1932x1916. Color fundus photograph. 45° FOV — 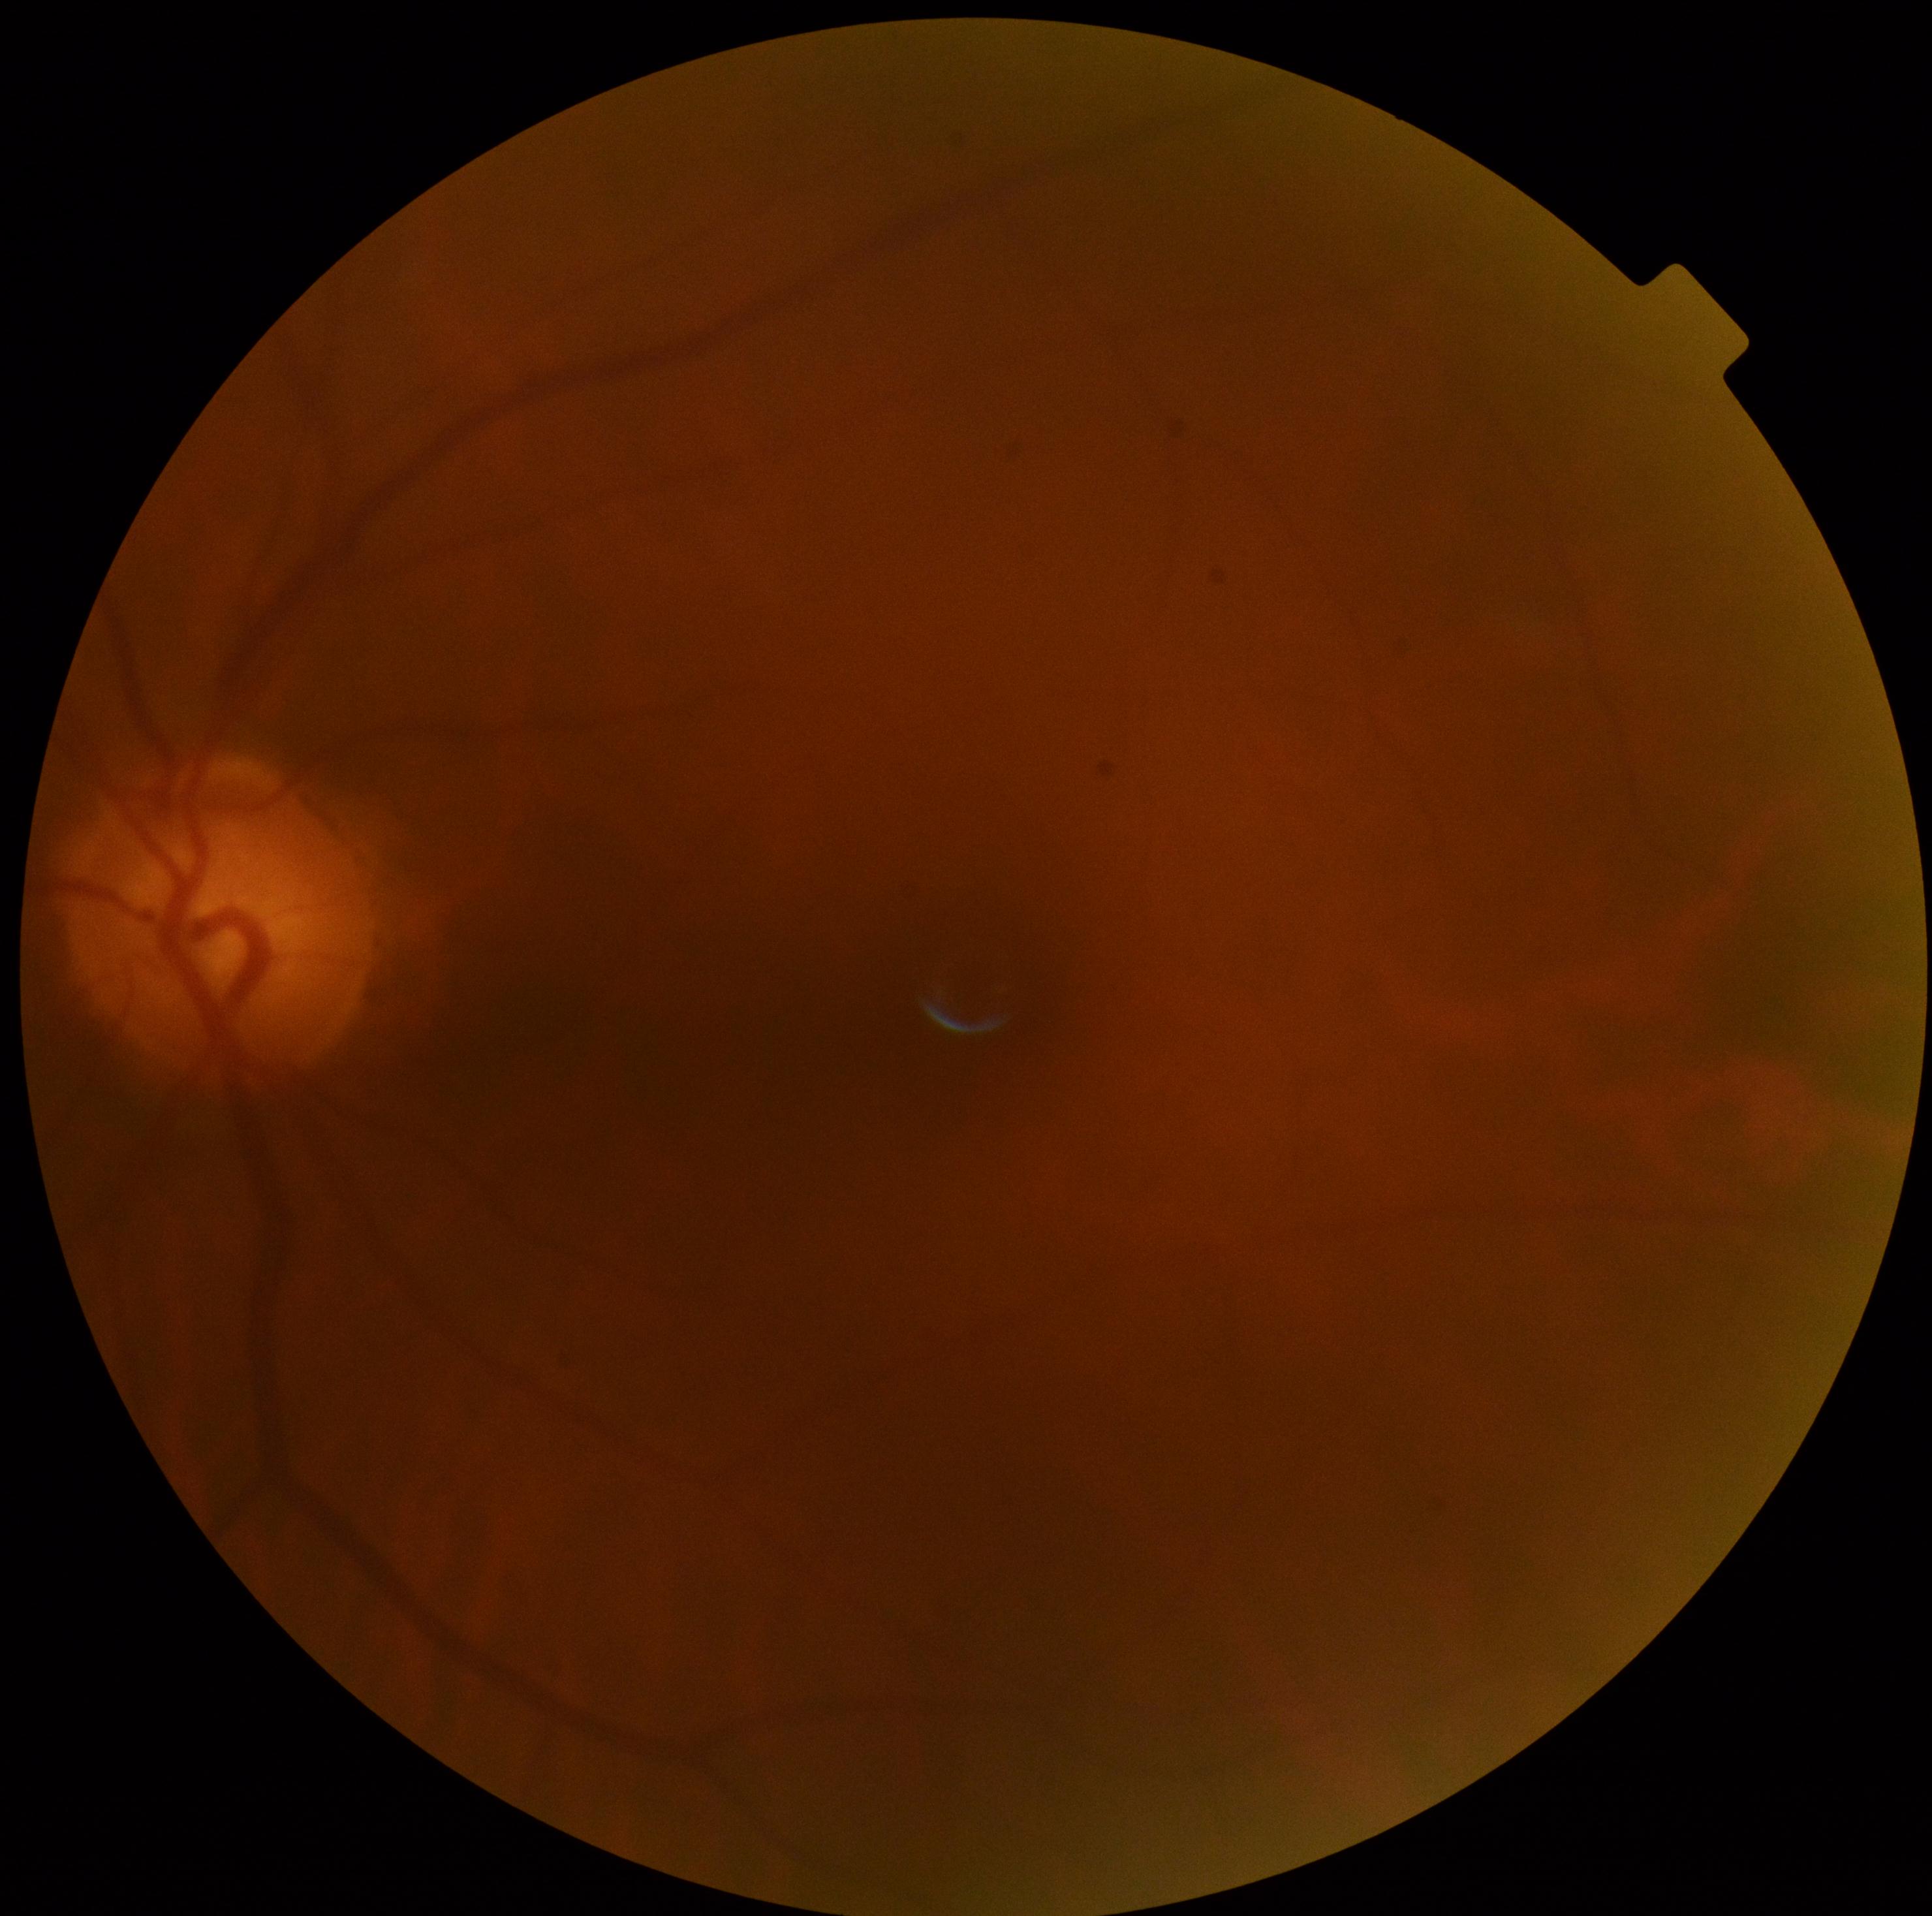

DR is grade 0 (no apparent retinopathy).